2352x1568px — 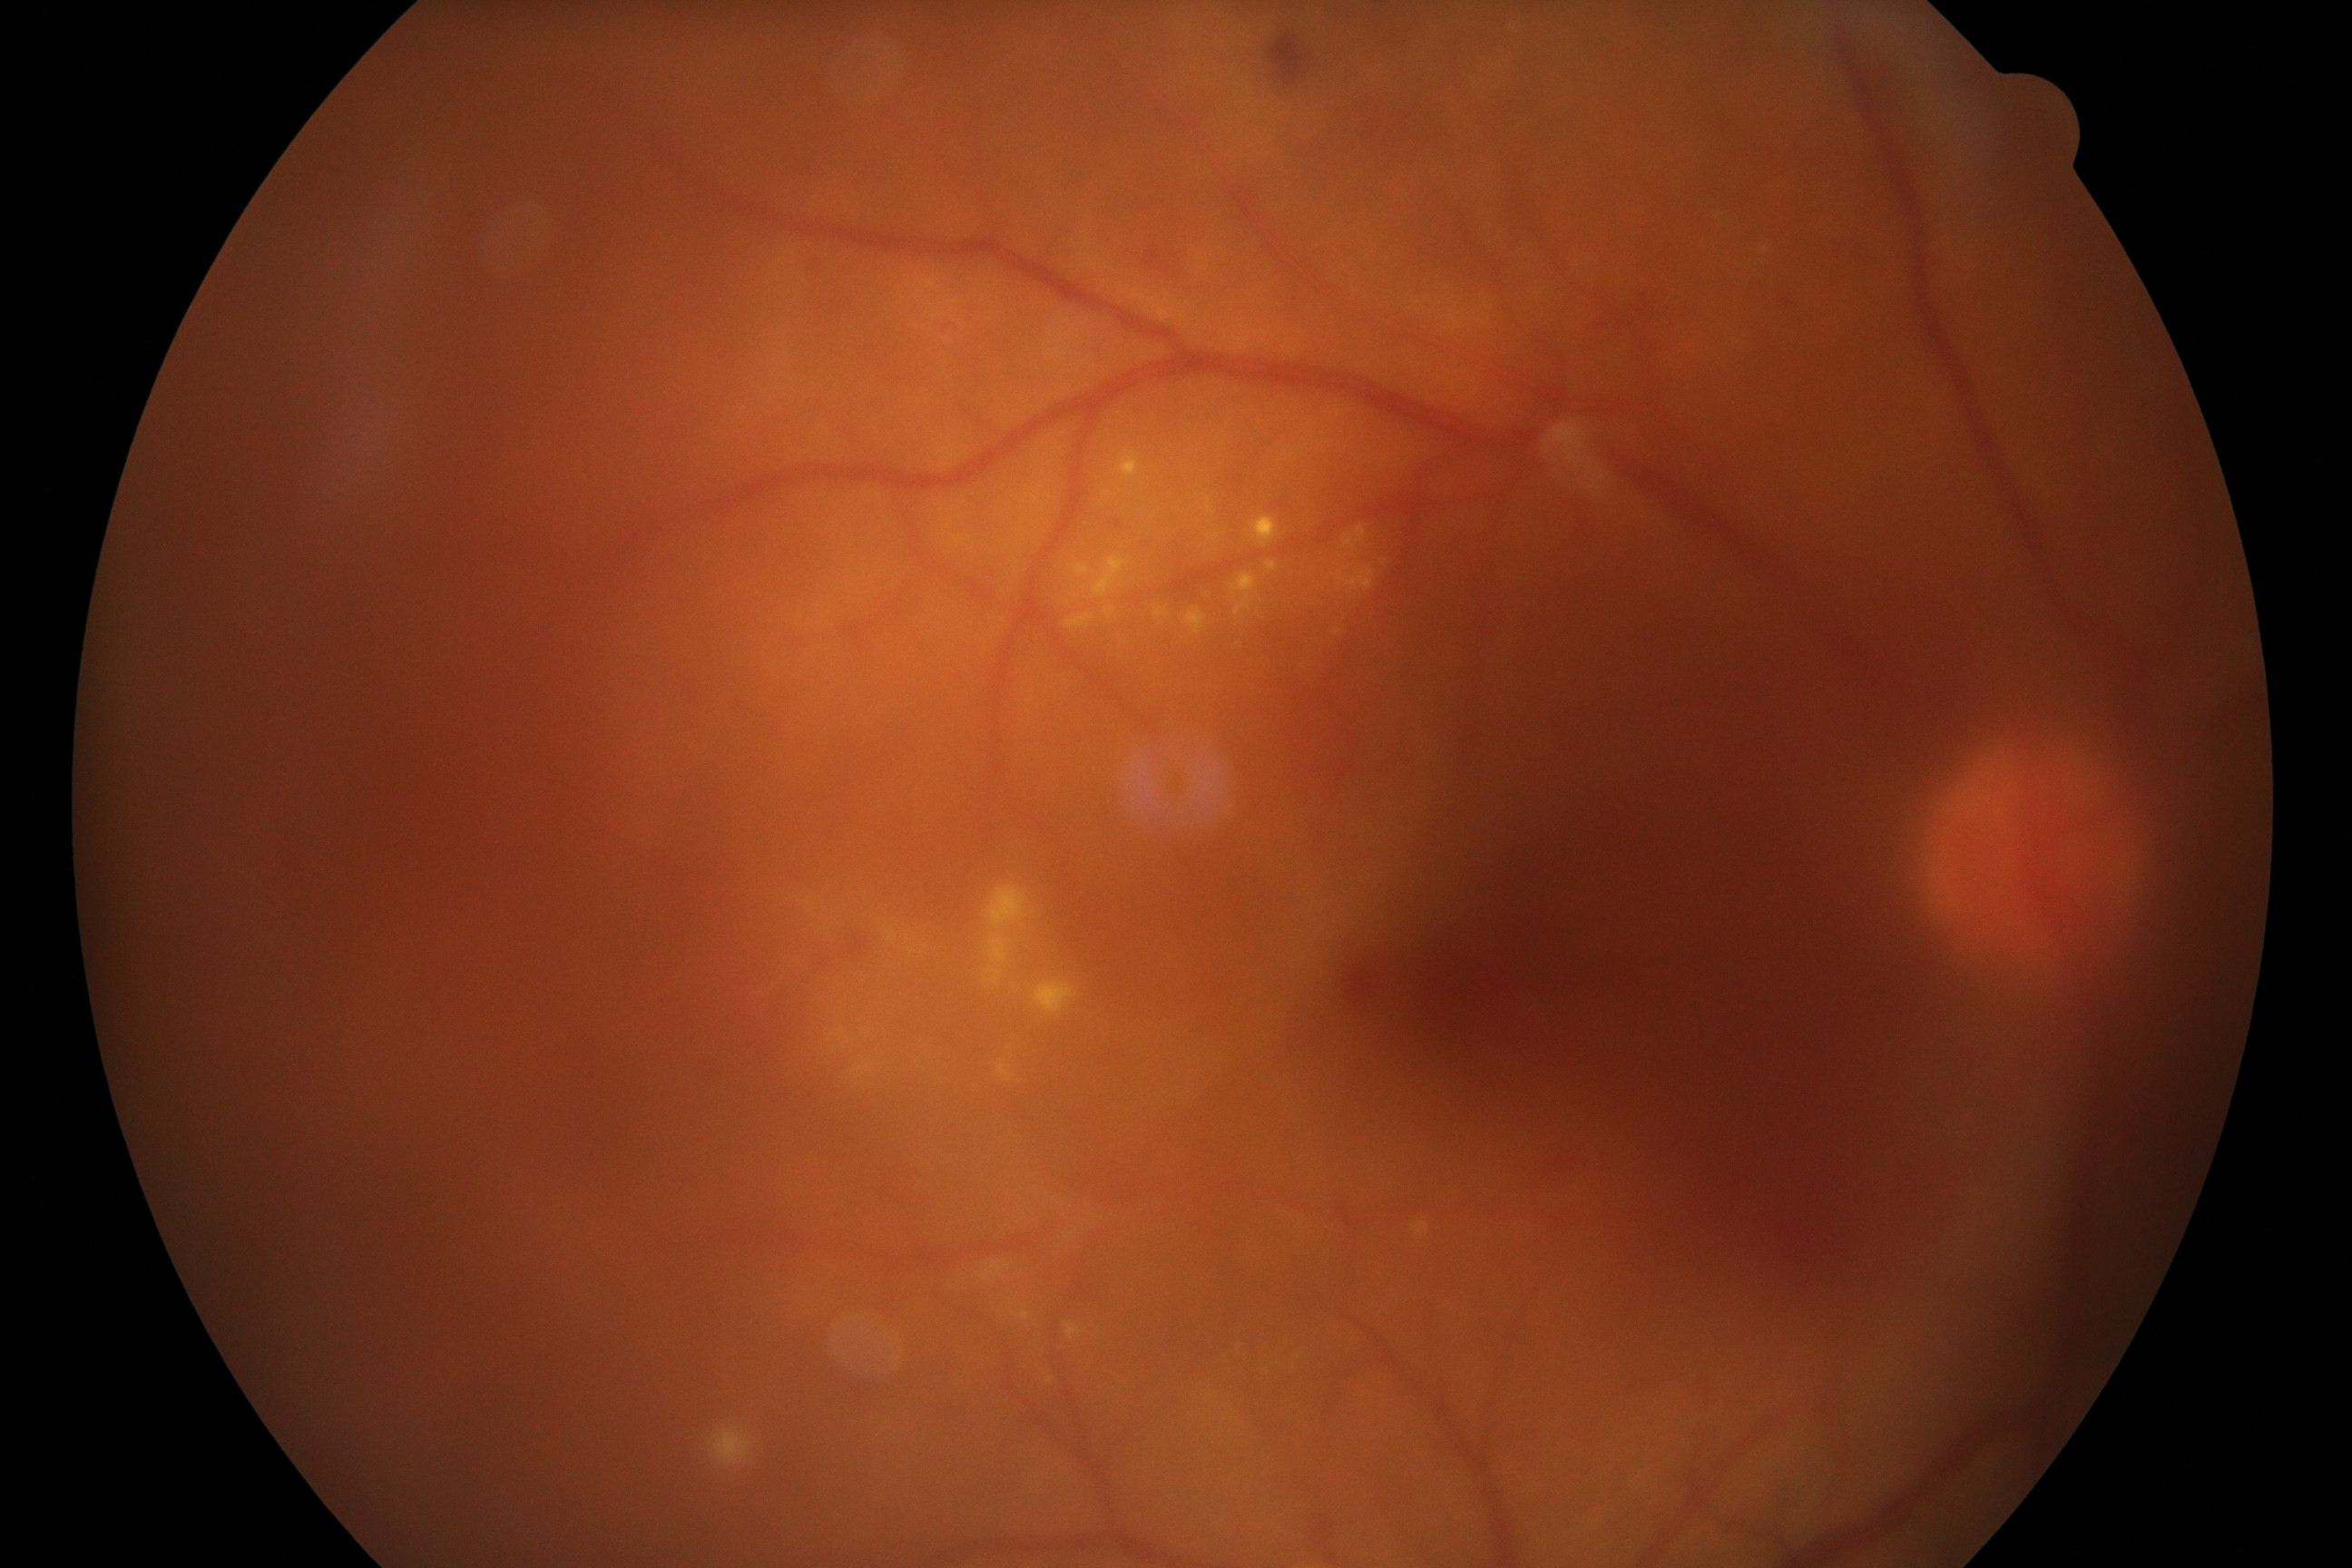

Gradability: poor.
Proliferative diabetic retinopathy: suspected, not confirmed.